Intraocular pressure (IOP) 17 mmHg by non-contact tonometry · visual field mean deviation: -0.21 dB · gender: M · refraction: sphere +1 D, cylinder -1.5 D, axis 75° · age 61 · axial length 23.42 mm · optic disc at the center of the field.
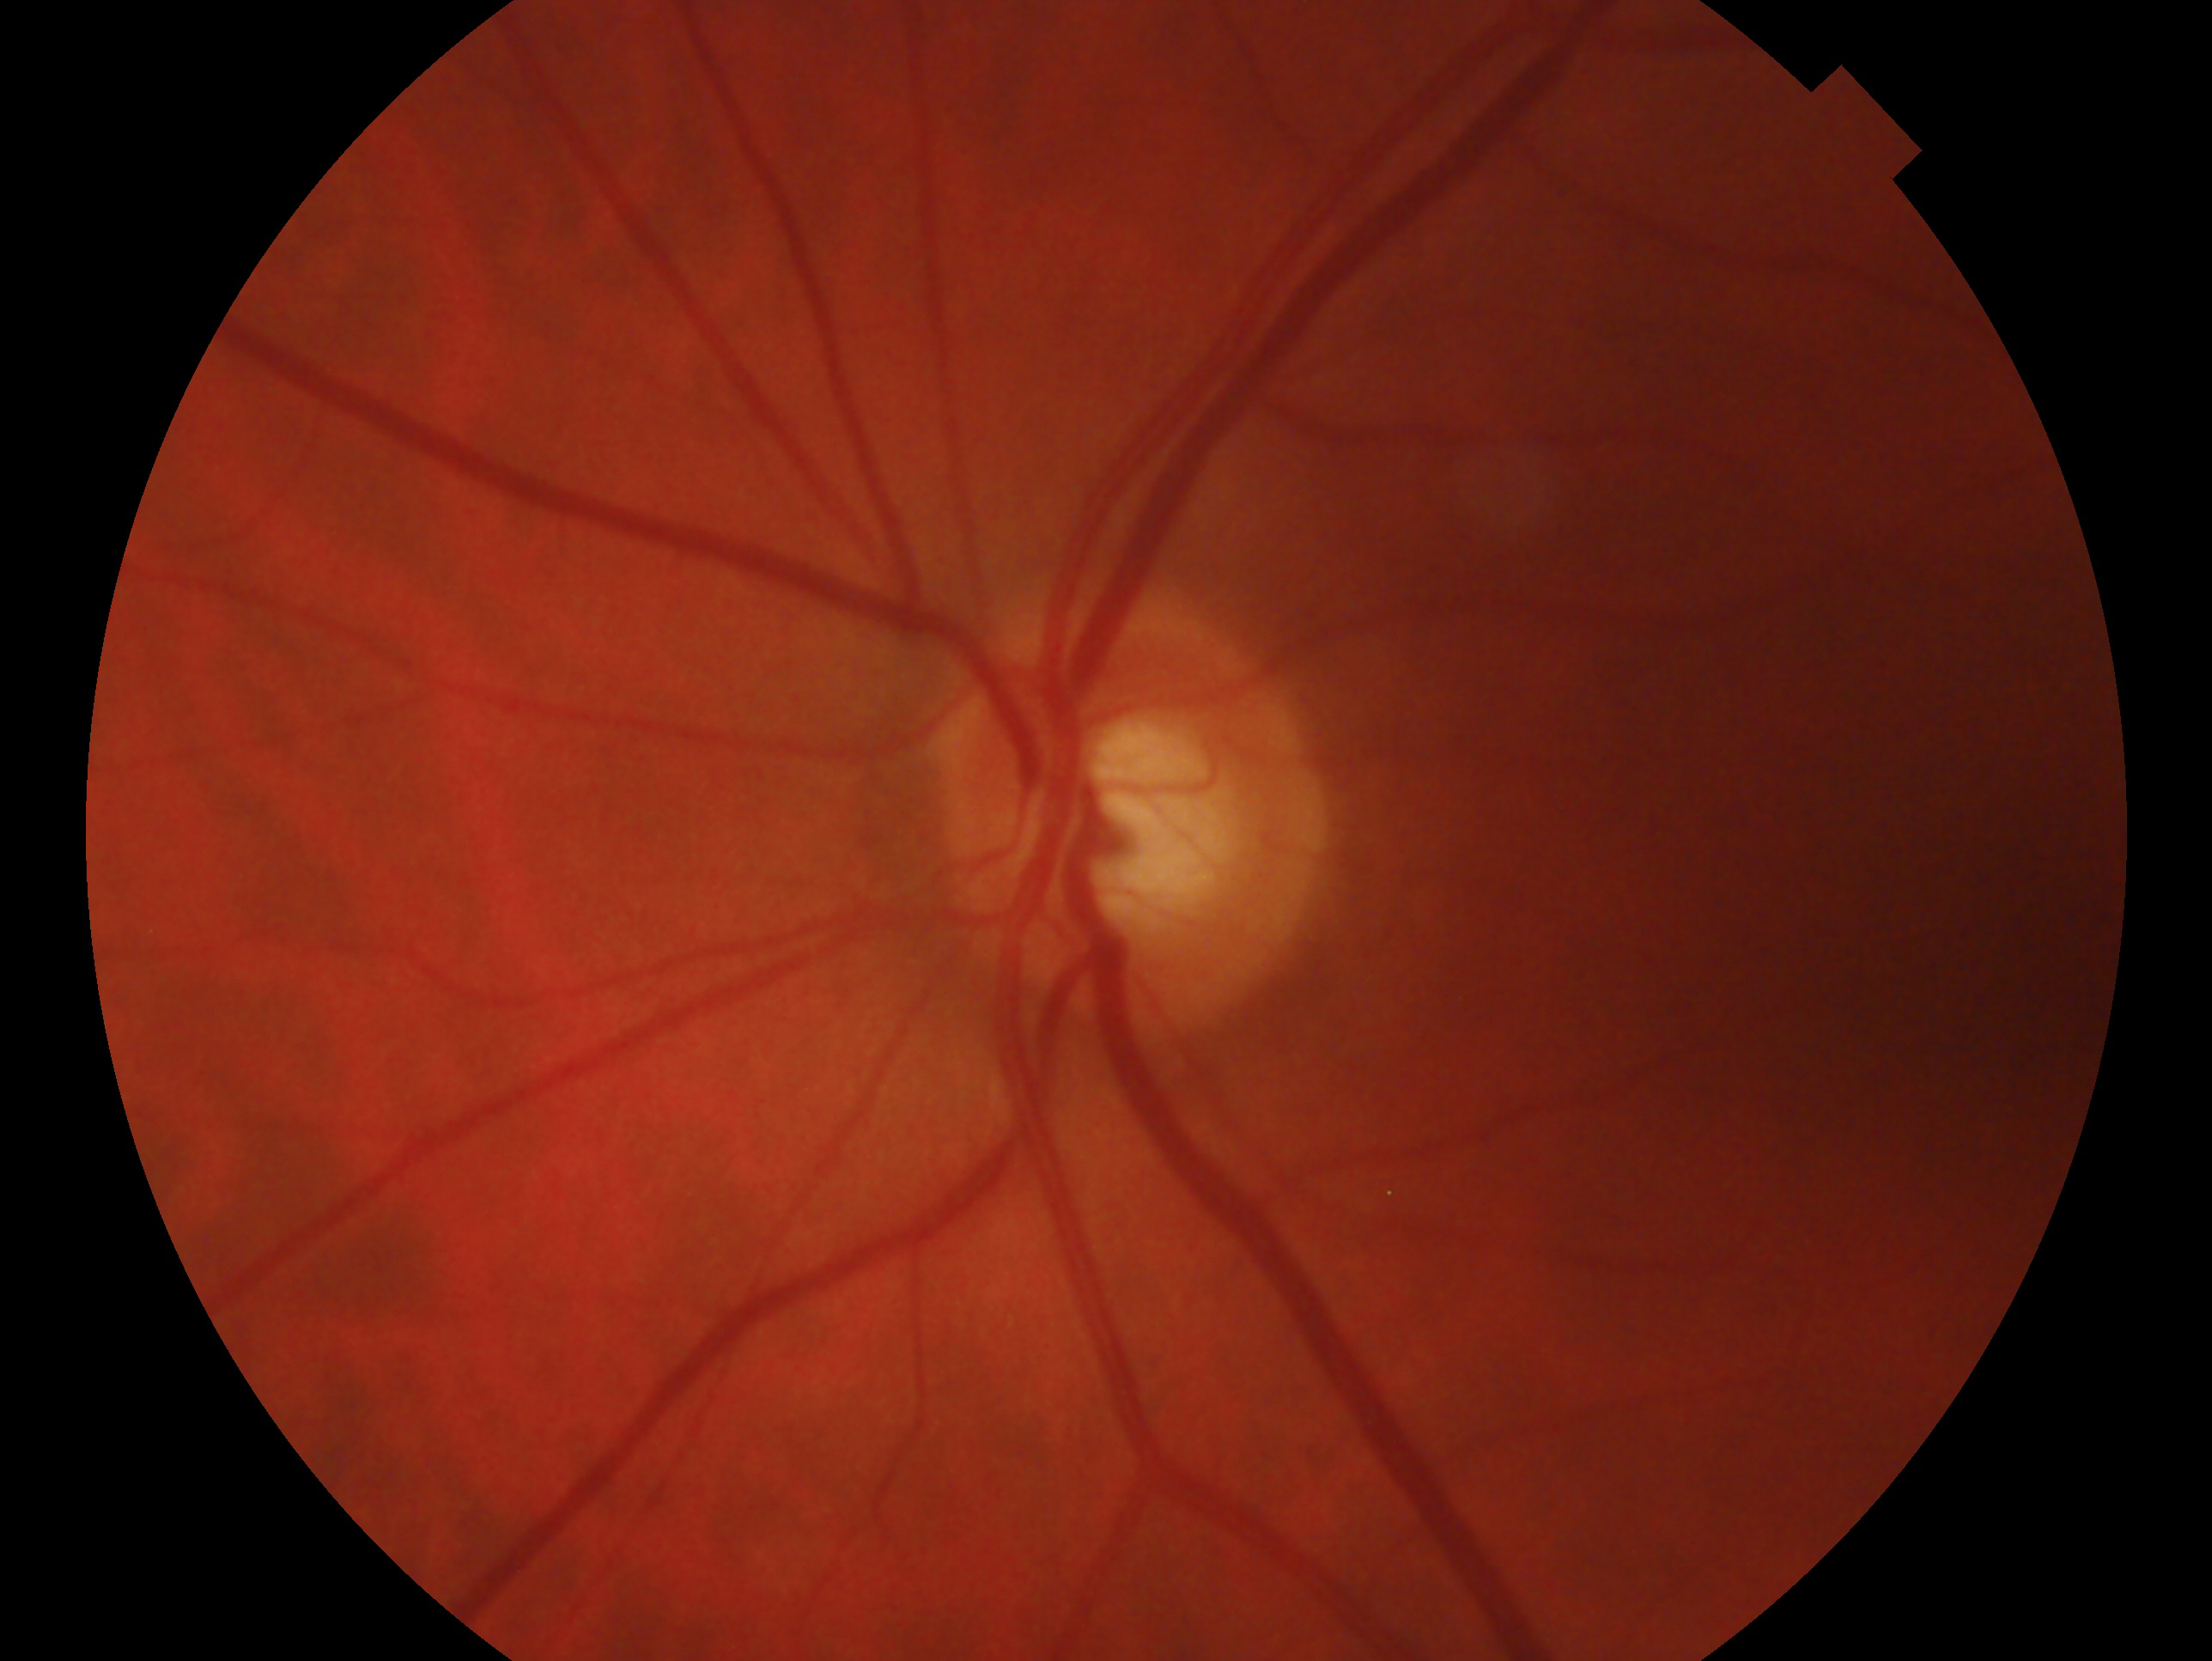

Diagnosis: consistent with glaucoma.
Imaged eye: OS.